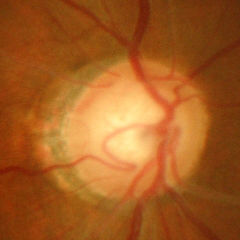 Optic disc appearance consistent with severe glaucomatous damage.